2212x1659, 45° FOV:
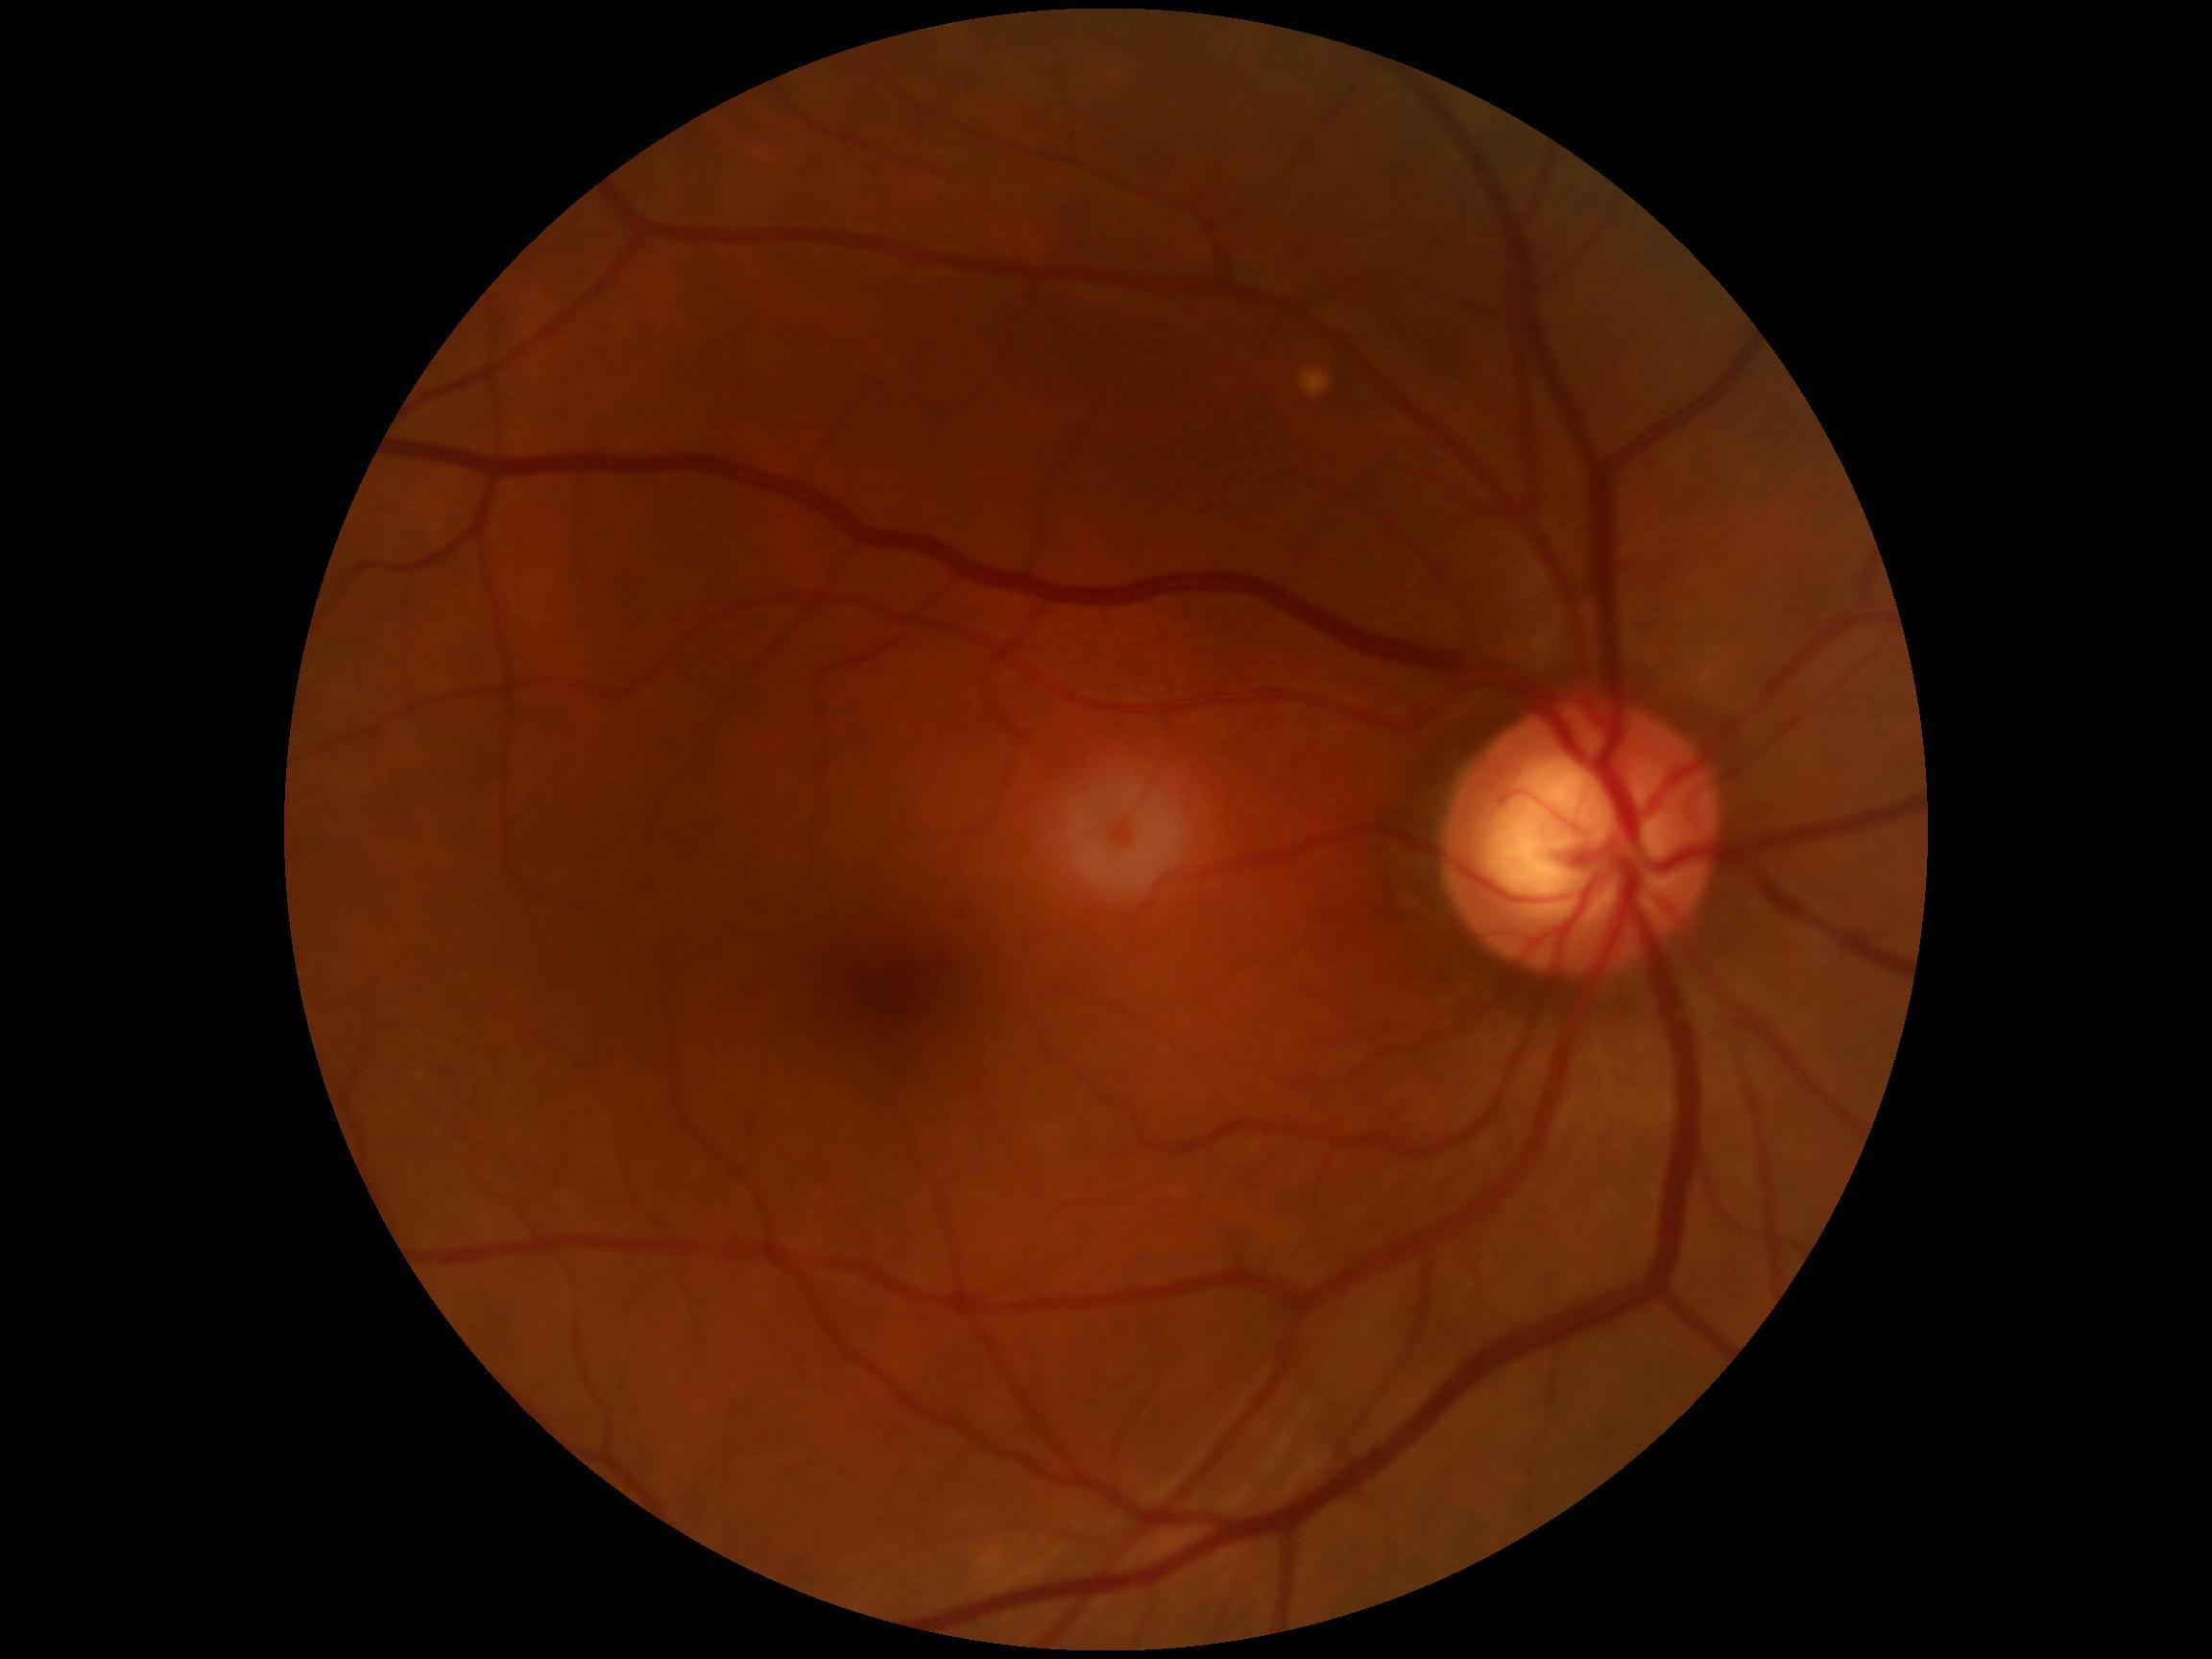

DR stage: no apparent diabetic retinopathy (grade 0).